2228 by 1652 pixels. Color fundus image. FOV: 50 degrees. Acquired with a Topcon TRC-50DX. Mydriatic (tropicamide and phenylephrine): 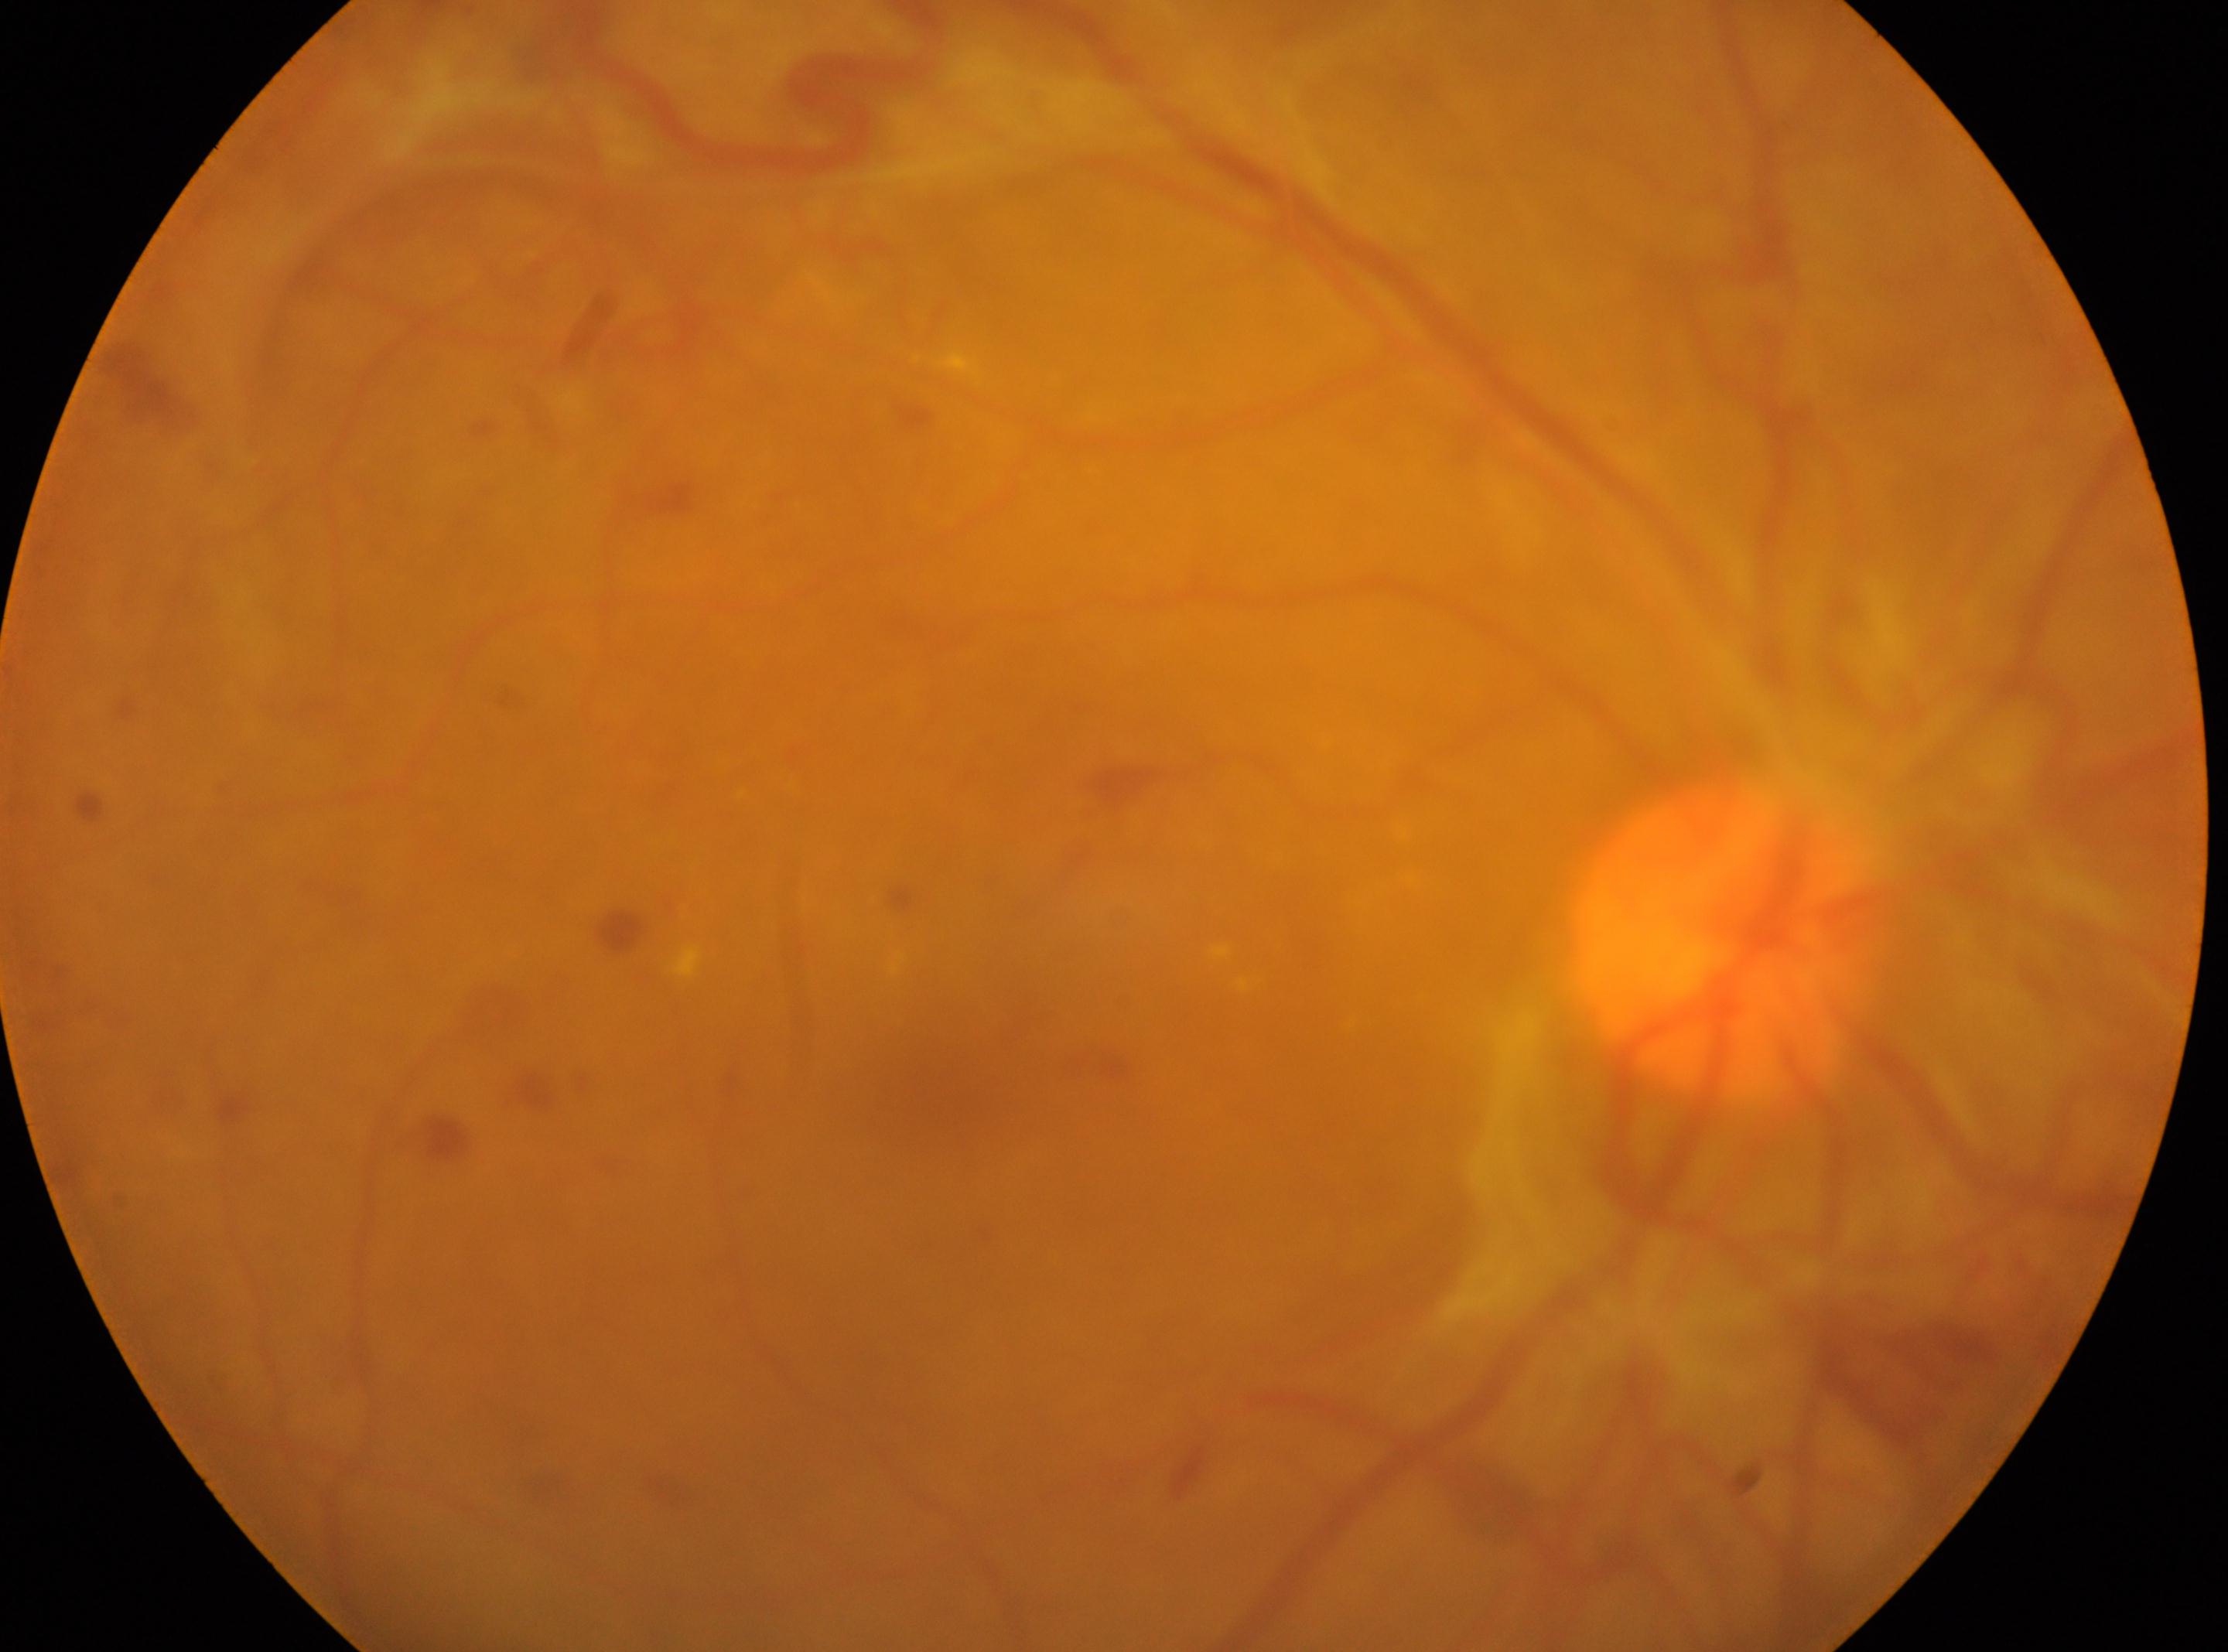 ONH: x=1724, y=947
macula center: x=938, y=1080
diabetic retinopathy (DR): 4/4
laterality: the right eye